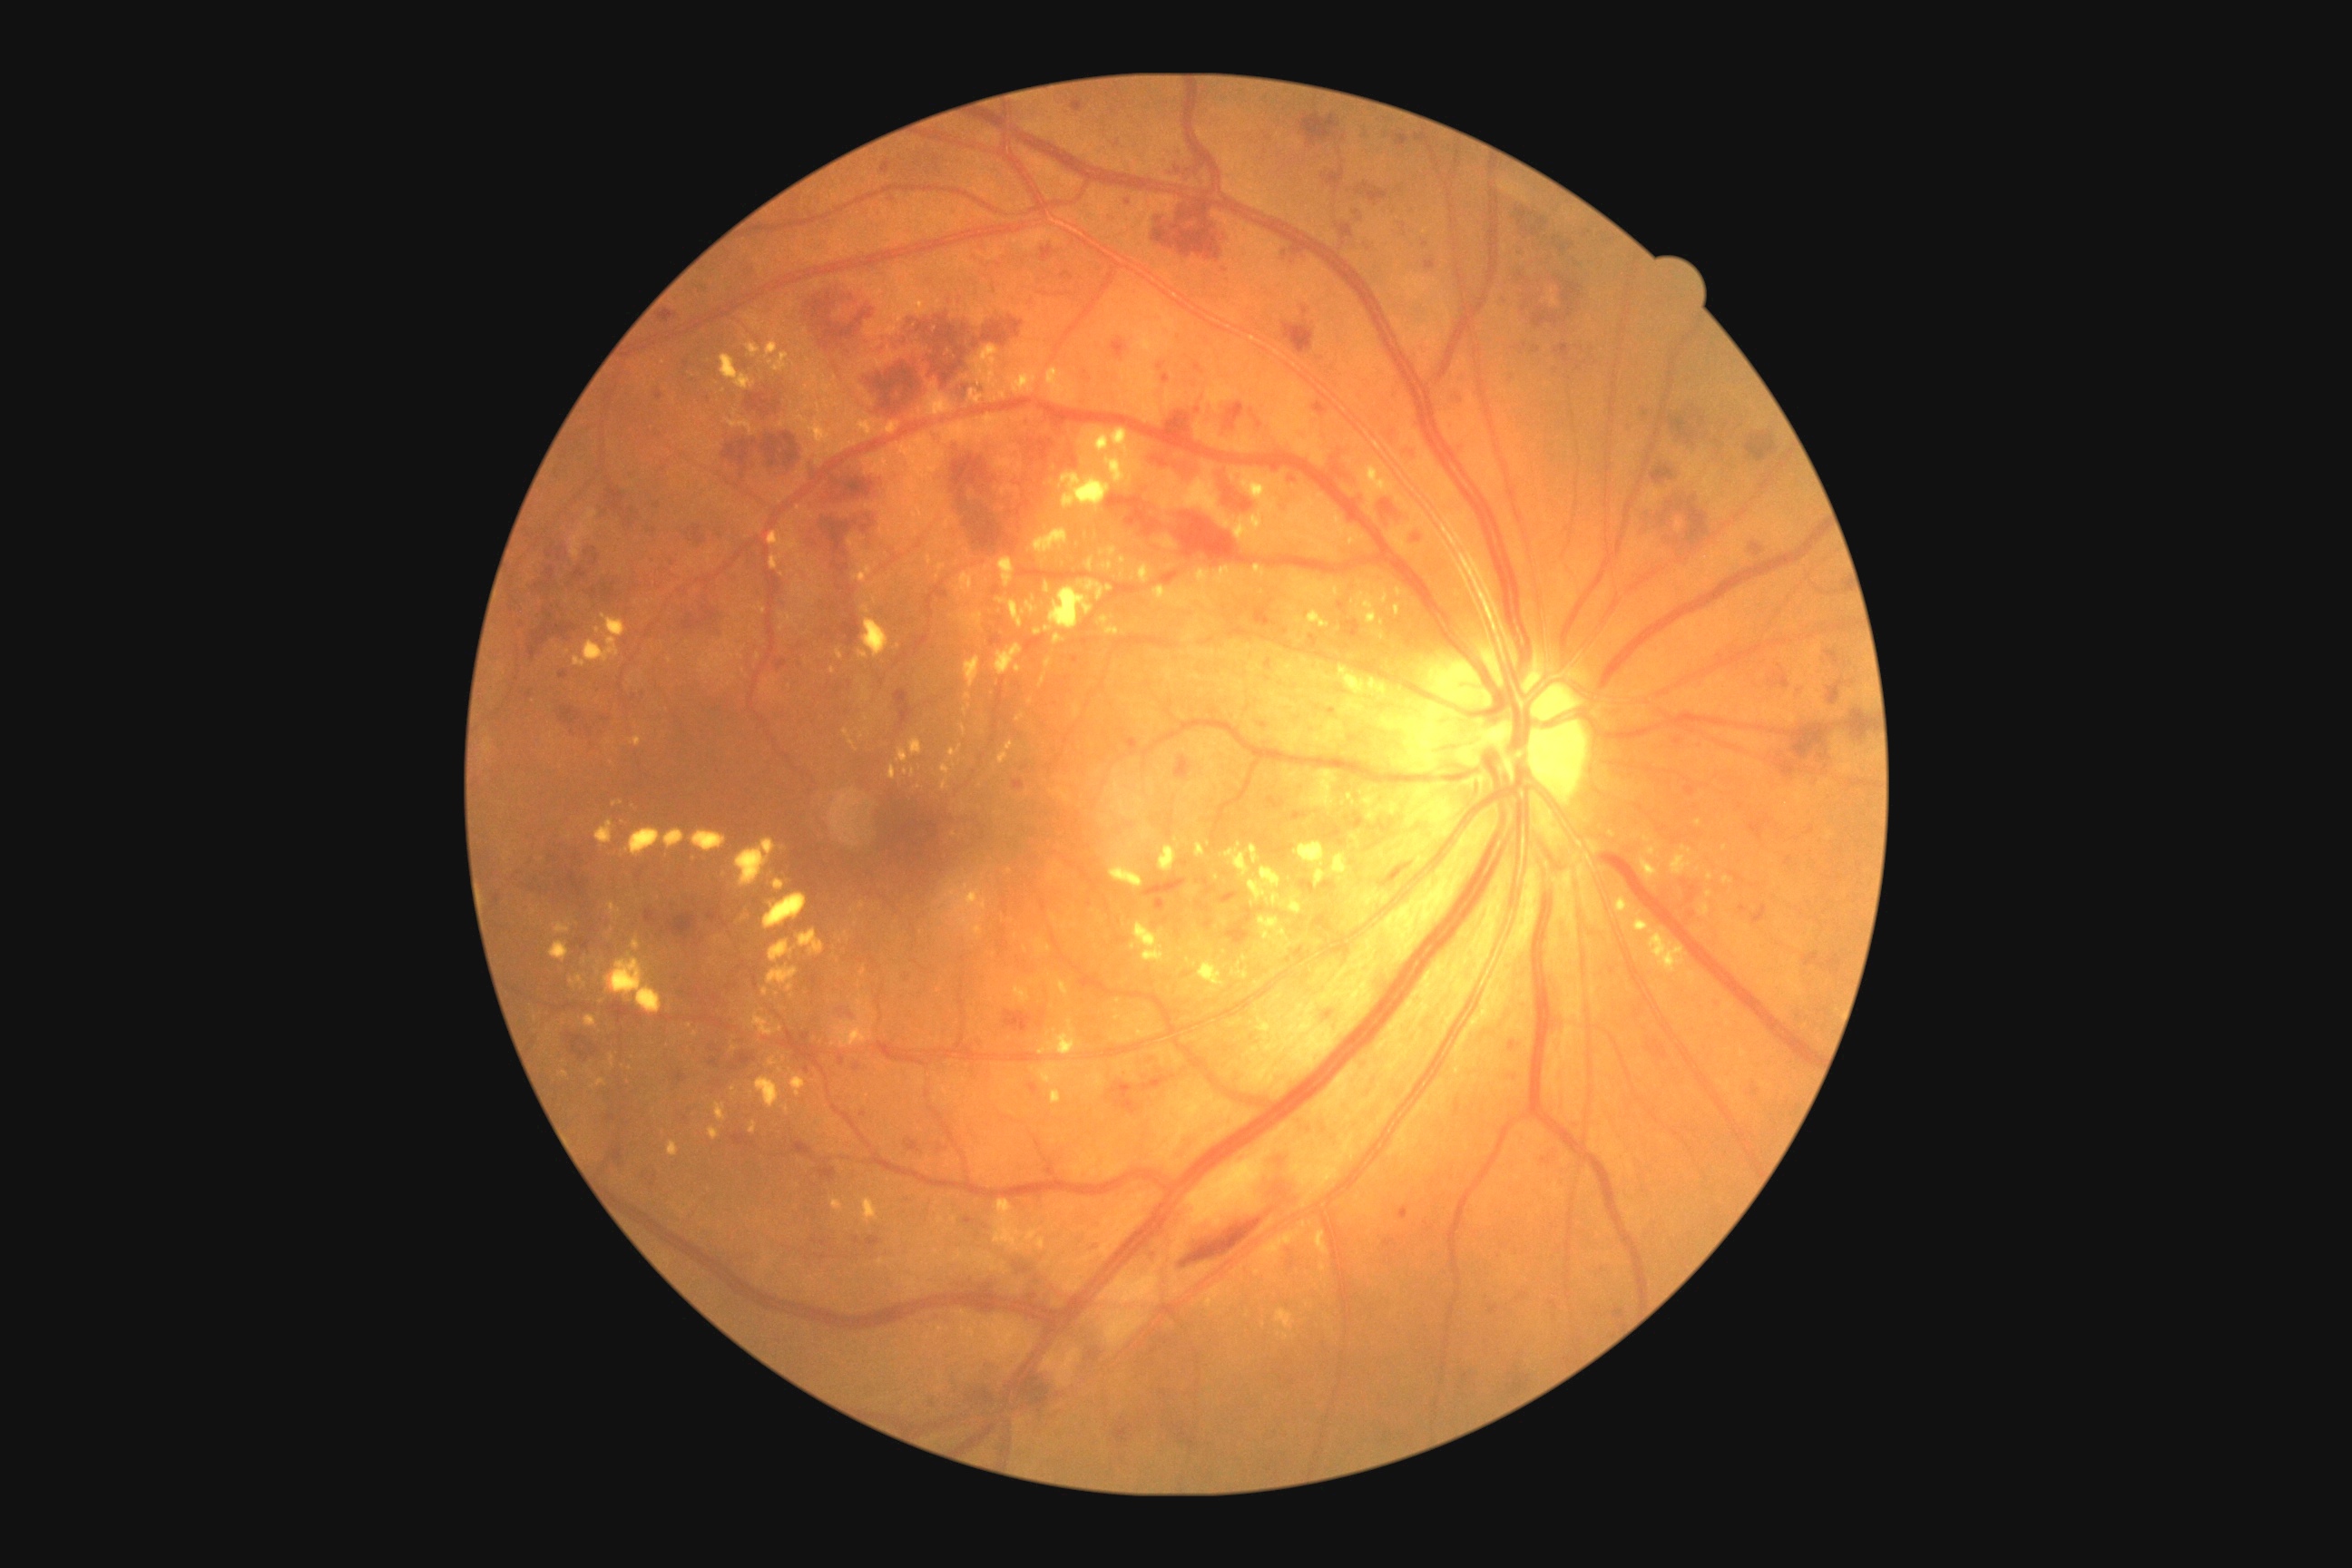 Diabetic retinopathy (DR): grade 3 (severe NPDR)
Representative lesions:
hemorrhages (HEs) (continued): [x1=867, y1=364, x2=919, y2=411]; [x1=1320, y1=148, x2=1346, y2=195]; [x1=576, y1=939, x2=593, y2=950]; [x1=818, y1=426, x2=919, y2=504]; [x1=709, y1=1039, x2=727, y2=1088]; [x1=565, y1=872, x2=587, y2=897]; [x1=1039, y1=438, x2=1055, y2=464]; [x1=1674, y1=876, x2=1703, y2=932]; [x1=1041, y1=246, x2=1055, y2=262]; [x1=943, y1=1360, x2=1008, y2=1409]; [x1=1803, y1=954, x2=1825, y2=968]; [x1=1193, y1=407, x2=1200, y2=415]; [x1=558, y1=547, x2=565, y2=562]; [x1=1113, y1=1418, x2=1133, y2=1444]; [x1=1112, y1=338, x2=1128, y2=360]; [x1=1162, y1=1424, x2=1200, y2=1451]; [x1=1384, y1=856, x2=1416, y2=879]; [x1=1028, y1=446, x2=1037, y2=455]
Small HEs approximately at point(819, 391); point(821, 381)
hard exudates (EXs) (continued): [x1=1308, y1=611, x2=1331, y2=629]; [x1=596, y1=1079, x2=607, y2=1086]; [x1=1037, y1=1064, x2=1068, y2=1086]; [x1=867, y1=808, x2=872, y2=818]; [x1=1197, y1=957, x2=1226, y2=986]; [x1=774, y1=879, x2=785, y2=890]; [x1=1195, y1=843, x2=1206, y2=858]; [x1=1191, y1=943, x2=1200, y2=950]; [x1=1250, y1=847, x2=1302, y2=939]; [x1=774, y1=353, x2=790, y2=373]; [x1=720, y1=355, x2=756, y2=391]; [x1=943, y1=765, x2=950, y2=790]; [x1=936, y1=415, x2=1004, y2=446]; [x1=1099, y1=616, x2=1110, y2=625]; [x1=1672, y1=852, x2=1681, y2=879]
Small EXs approximately at point(1225, 922); point(1099, 773); point(792, 997); point(1011, 871)
microaneurysms (MAs) (continued): [x1=1533, y1=346, x2=1542, y2=353]; [x1=1344, y1=622, x2=1362, y2=640]; [x1=1554, y1=346, x2=1571, y2=364]; [x1=1028, y1=1083, x2=1039, y2=1095]; [x1=1162, y1=375, x2=1170, y2=384]; [x1=709, y1=1057, x2=720, y2=1068]; [x1=1411, y1=534, x2=1422, y2=544]; [x1=1124, y1=740, x2=1139, y2=756]; [x1=1115, y1=937, x2=1128, y2=945]; [x1=1509, y1=1041, x2=1522, y2=1055]; [x1=1041, y1=901, x2=1048, y2=912]; [x1=774, y1=660, x2=787, y2=671]; [x1=939, y1=591, x2=948, y2=600]; [x1=1614, y1=1309, x2=1625, y2=1320]; [x1=1280, y1=629, x2=1289, y2=634]; [x1=1260, y1=723, x2=1268, y2=729]; [x1=1253, y1=607, x2=1277, y2=627]
Small MAs approximately at point(664, 469); point(1209, 924); point(1129, 203)